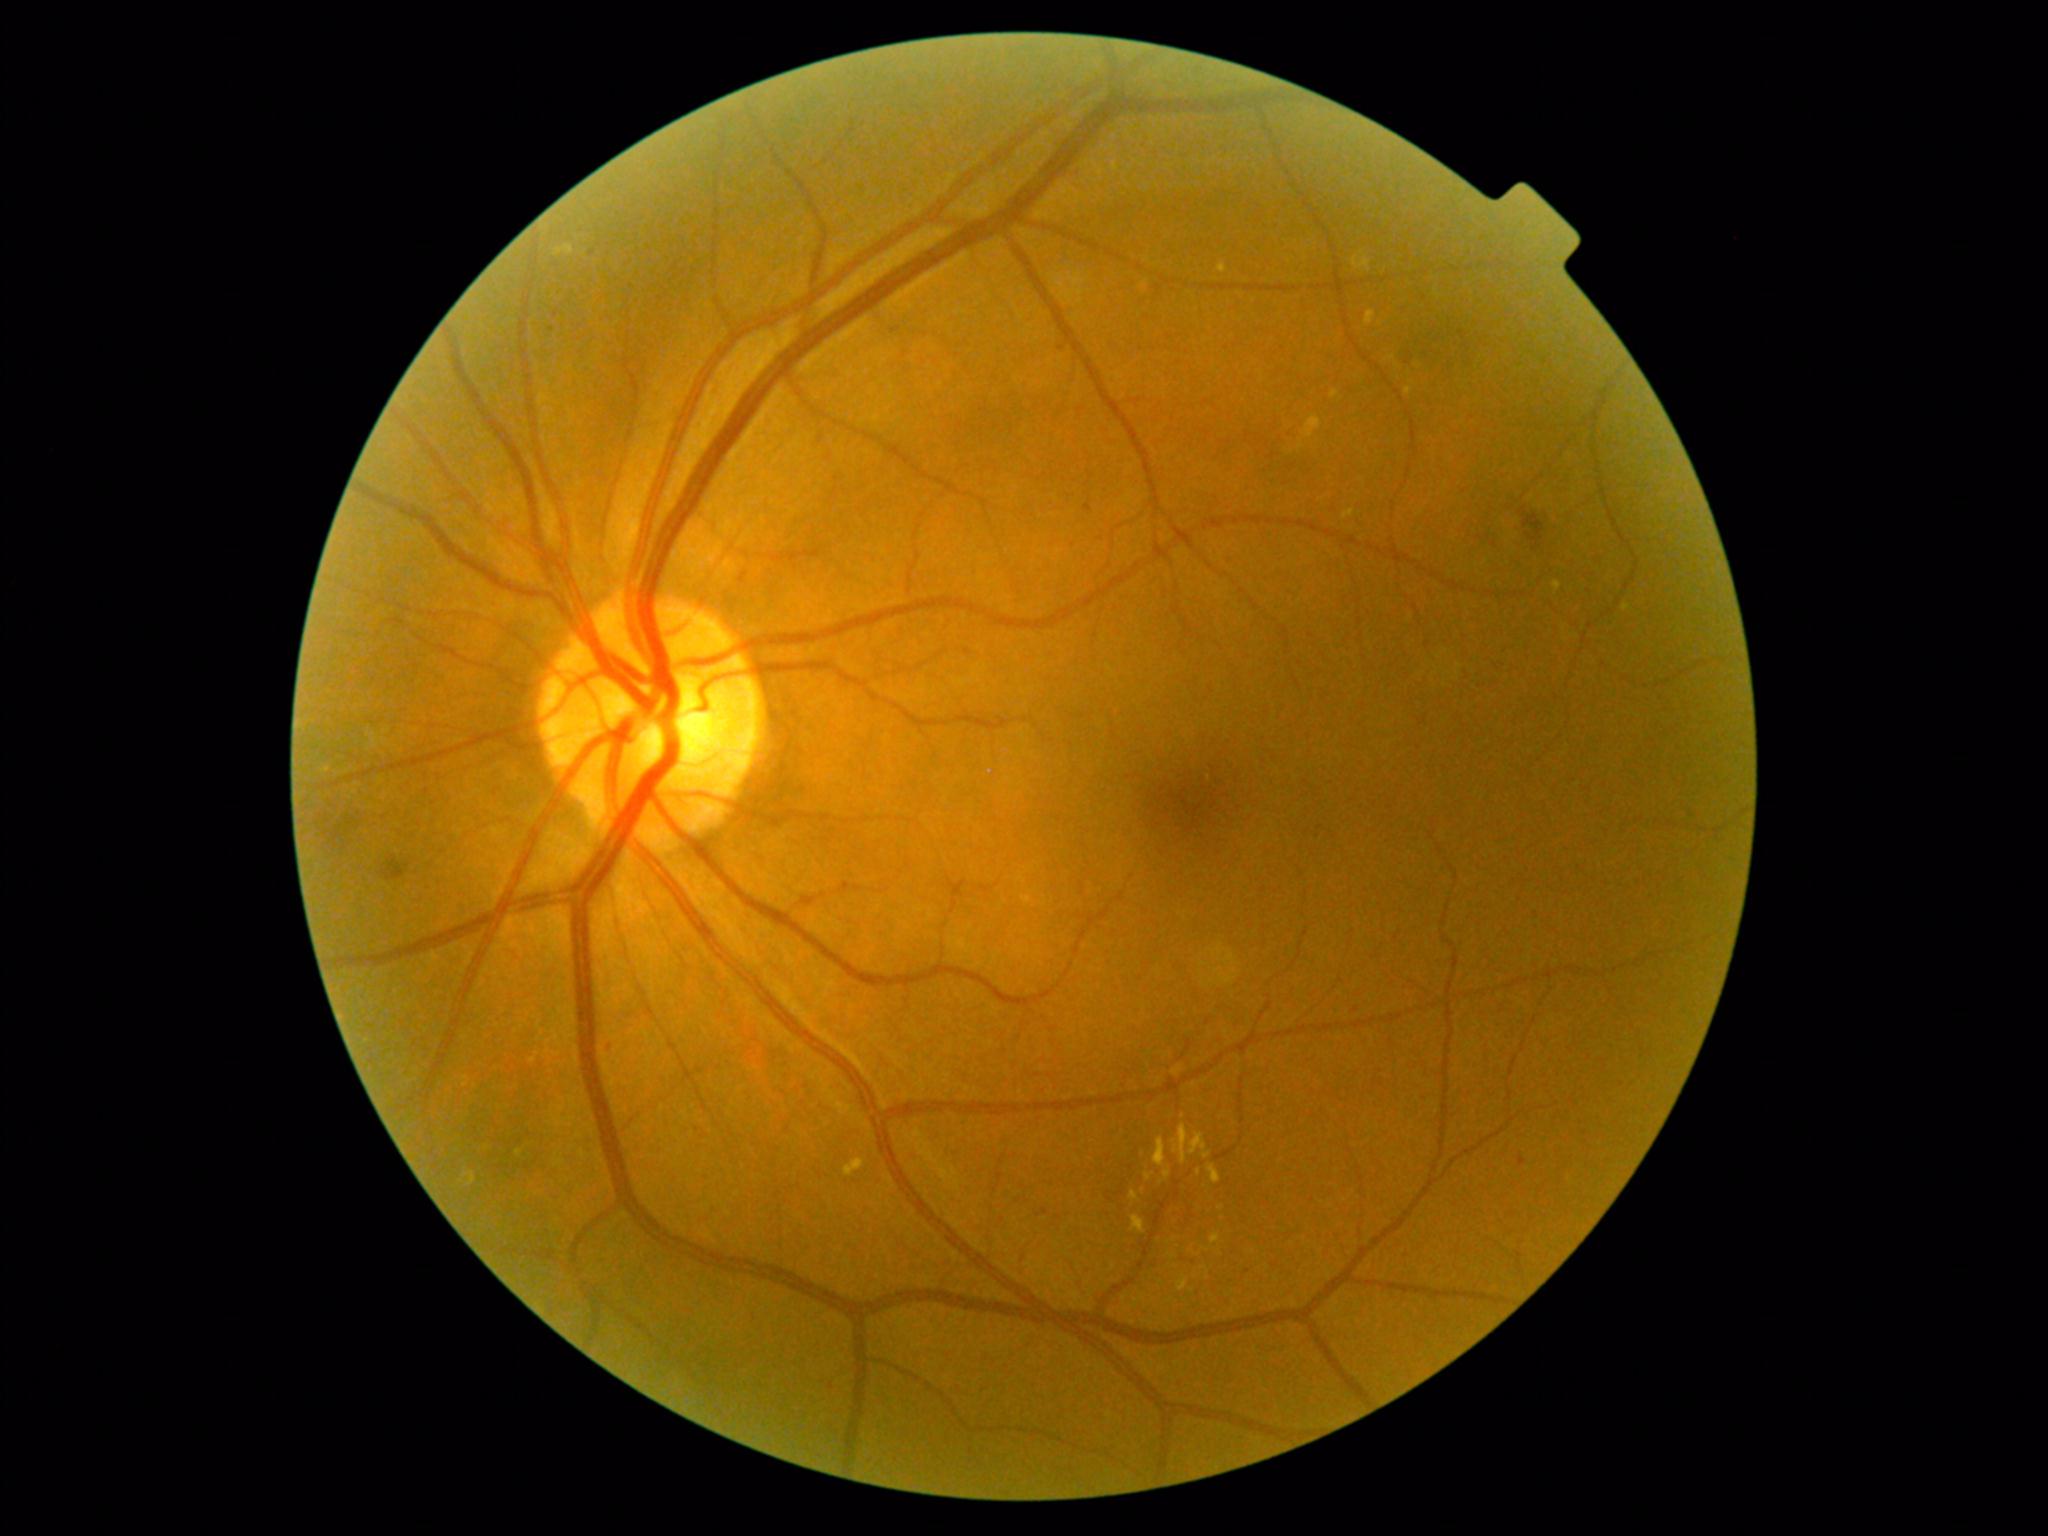 partial: true
dr_grade: 2
dr_grade_name: moderate NPDR
lesions:
  ex:
    - 1406/387/1413/396
    - 1218/264/1228/274
    - 1189/1133/1212/1160
    - 1353/251/1371/272
    - 1153/1137/1166/1167
    - 1331/390/1340/399
    - 1201/1266/1211/1280
    - 1365/311/1376/326
    - 1208/1164/1222/1184
    - 463/1171/476/1186
    - 1211/1233/1221/1244
  ex_small:
    - (1200, 1172)
    - (1172, 1256)
    - (1220, 1208)
    - (1161, 1281)
    - (519, 1153)